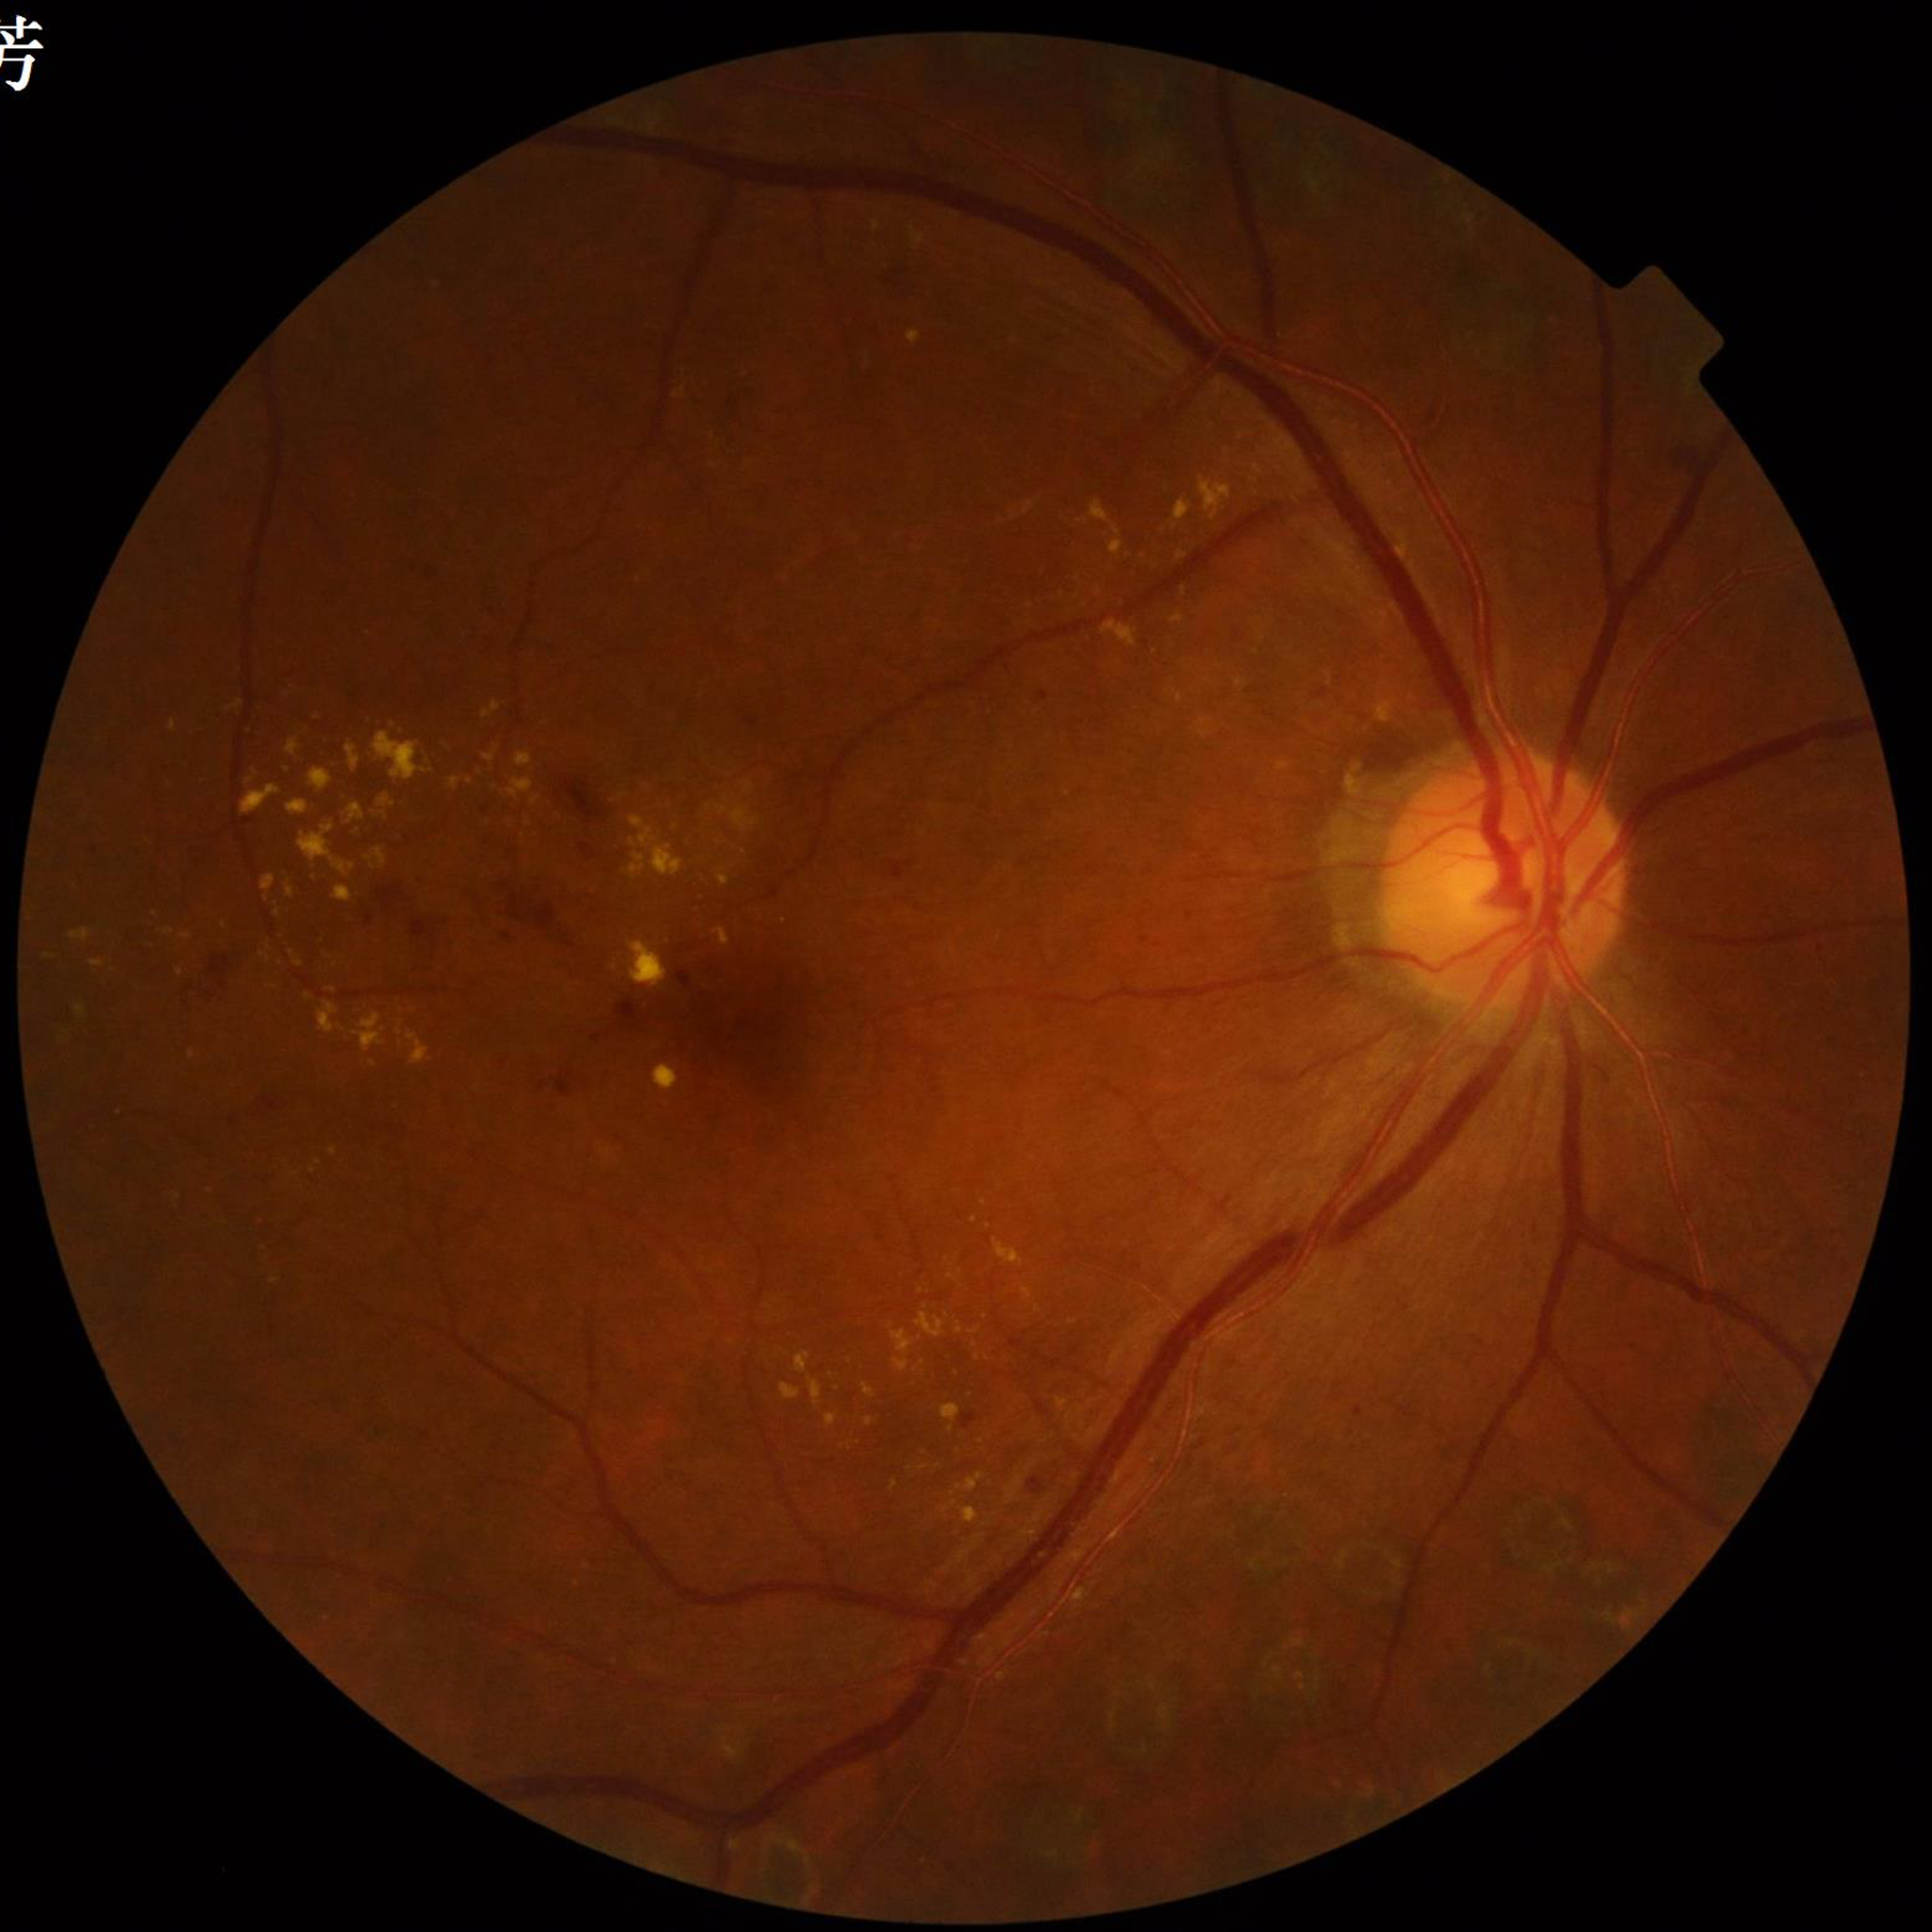

Disease: diabetic retinopathy